2352 x 1568 pixels
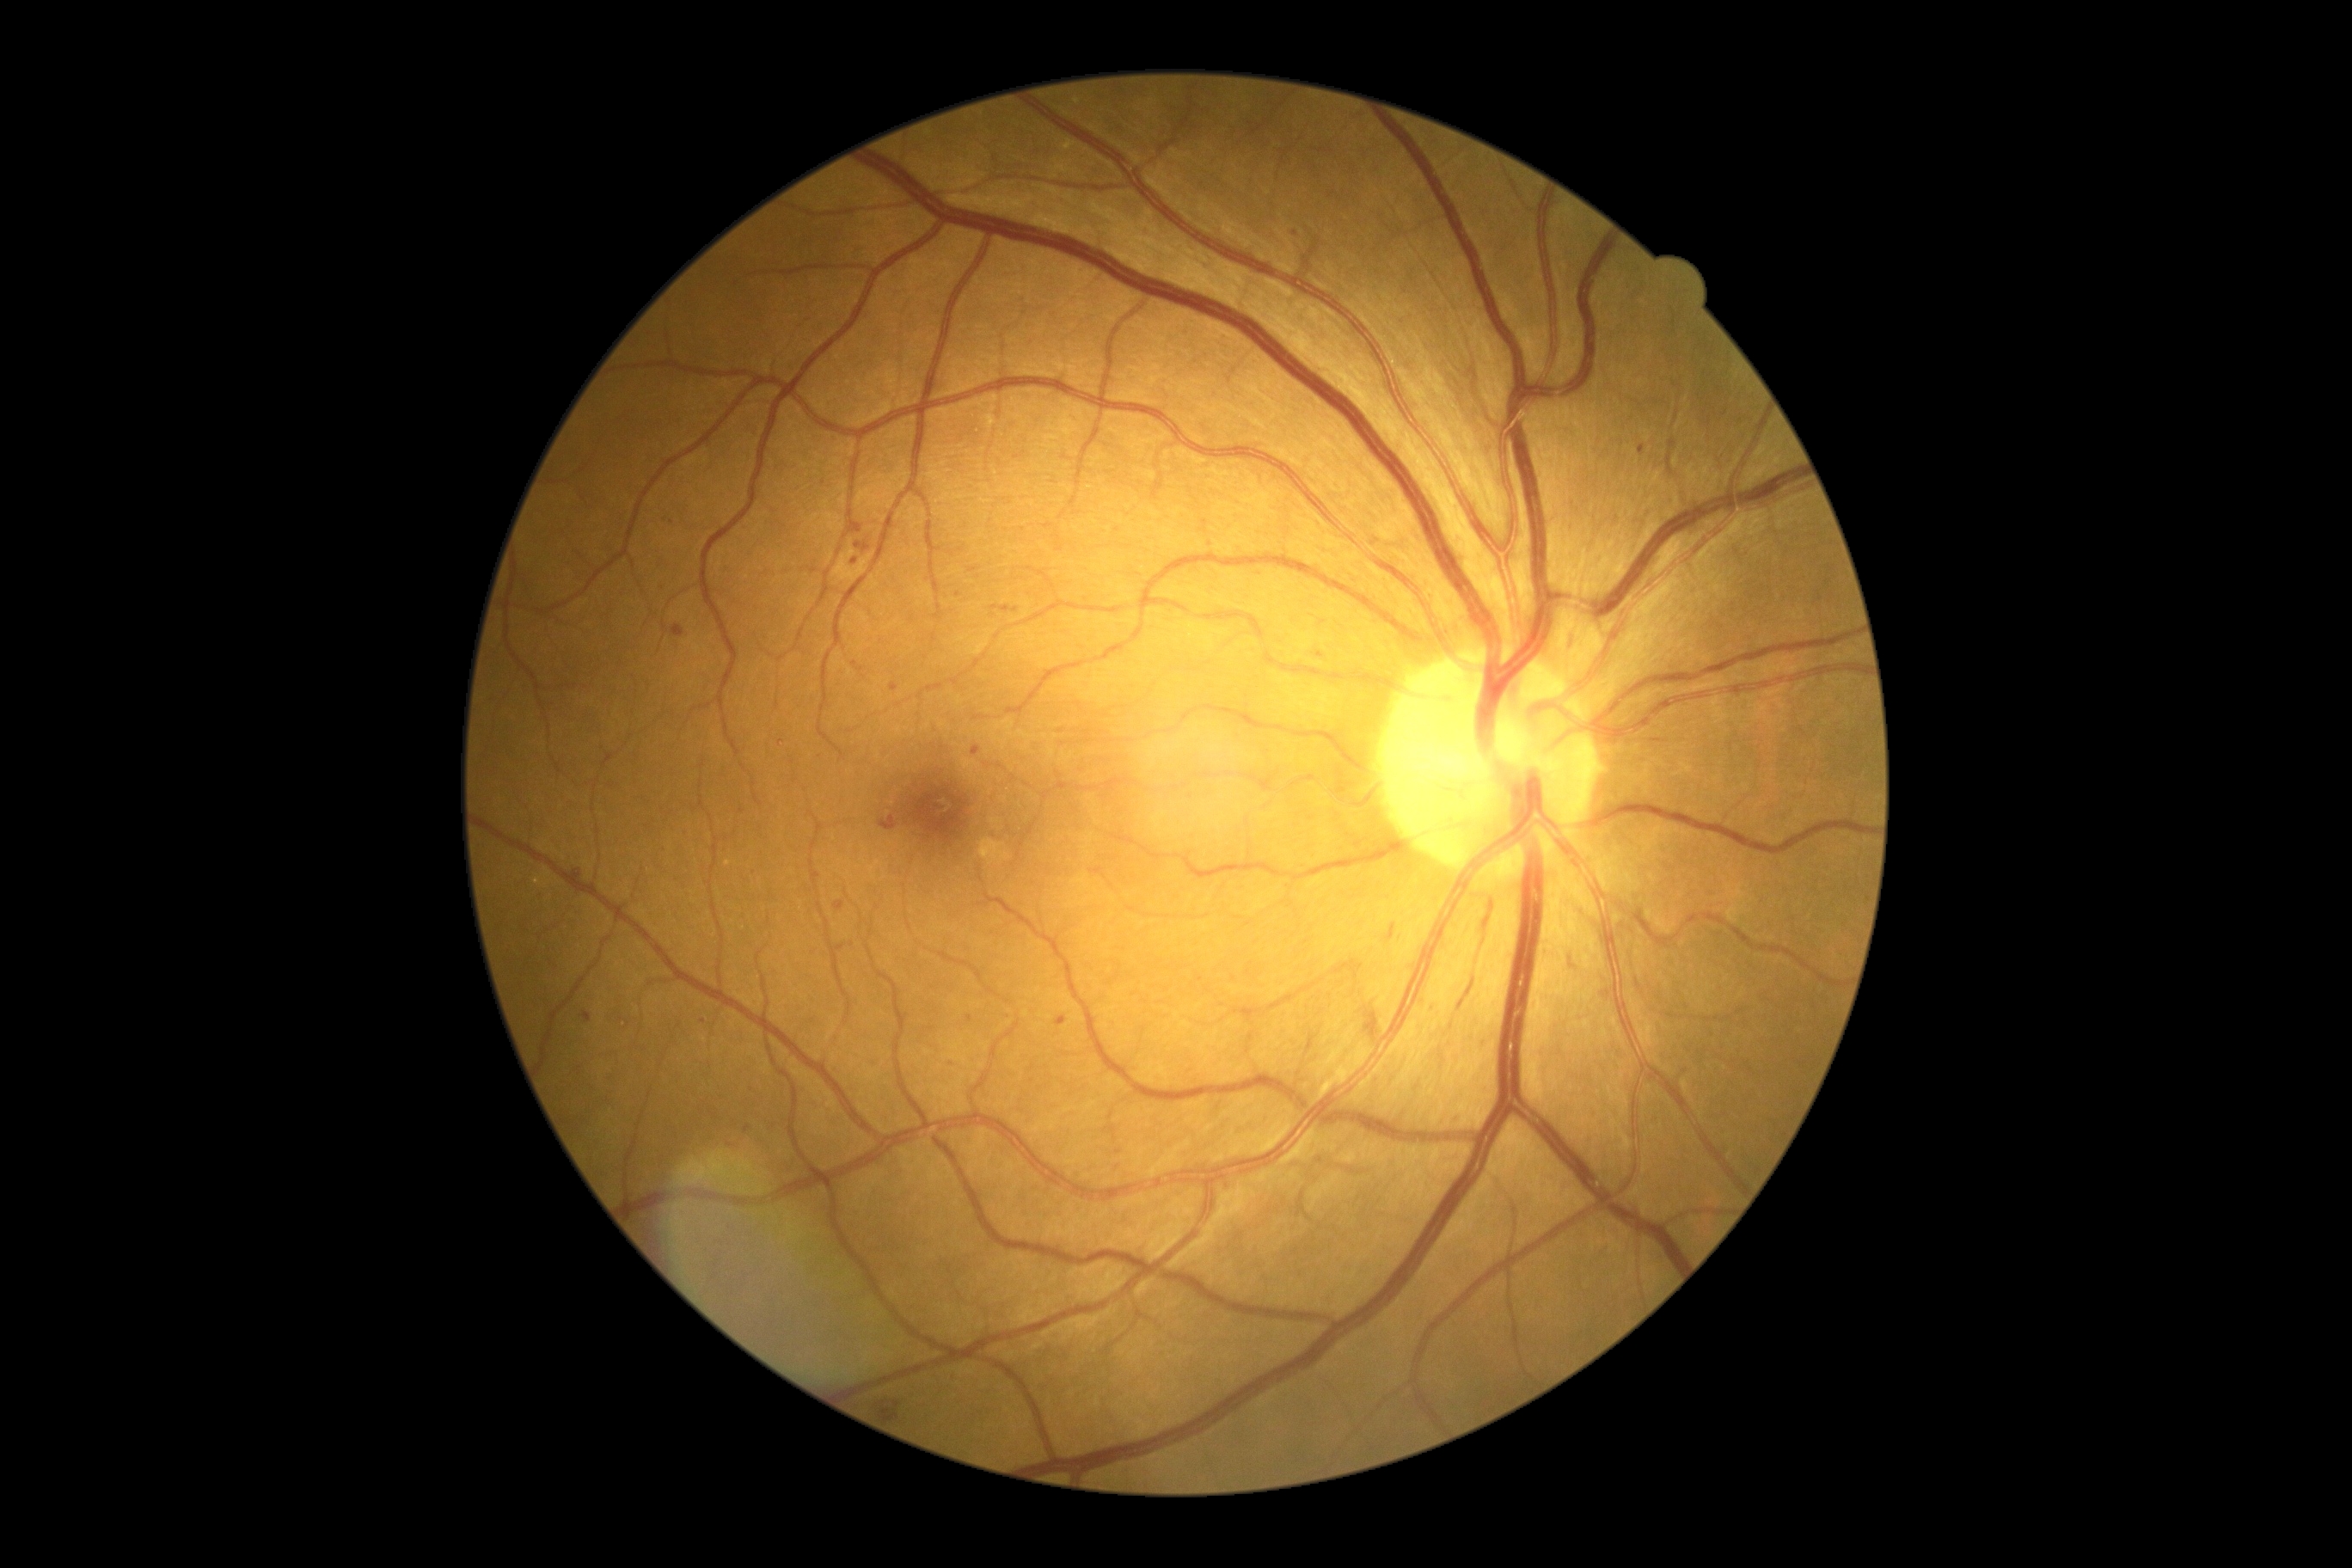
DR grade is 2 (moderate NPDR).